Camera: Remidio Fundus on Phone; color fundus photograph; 1659 x 2212 pixels.
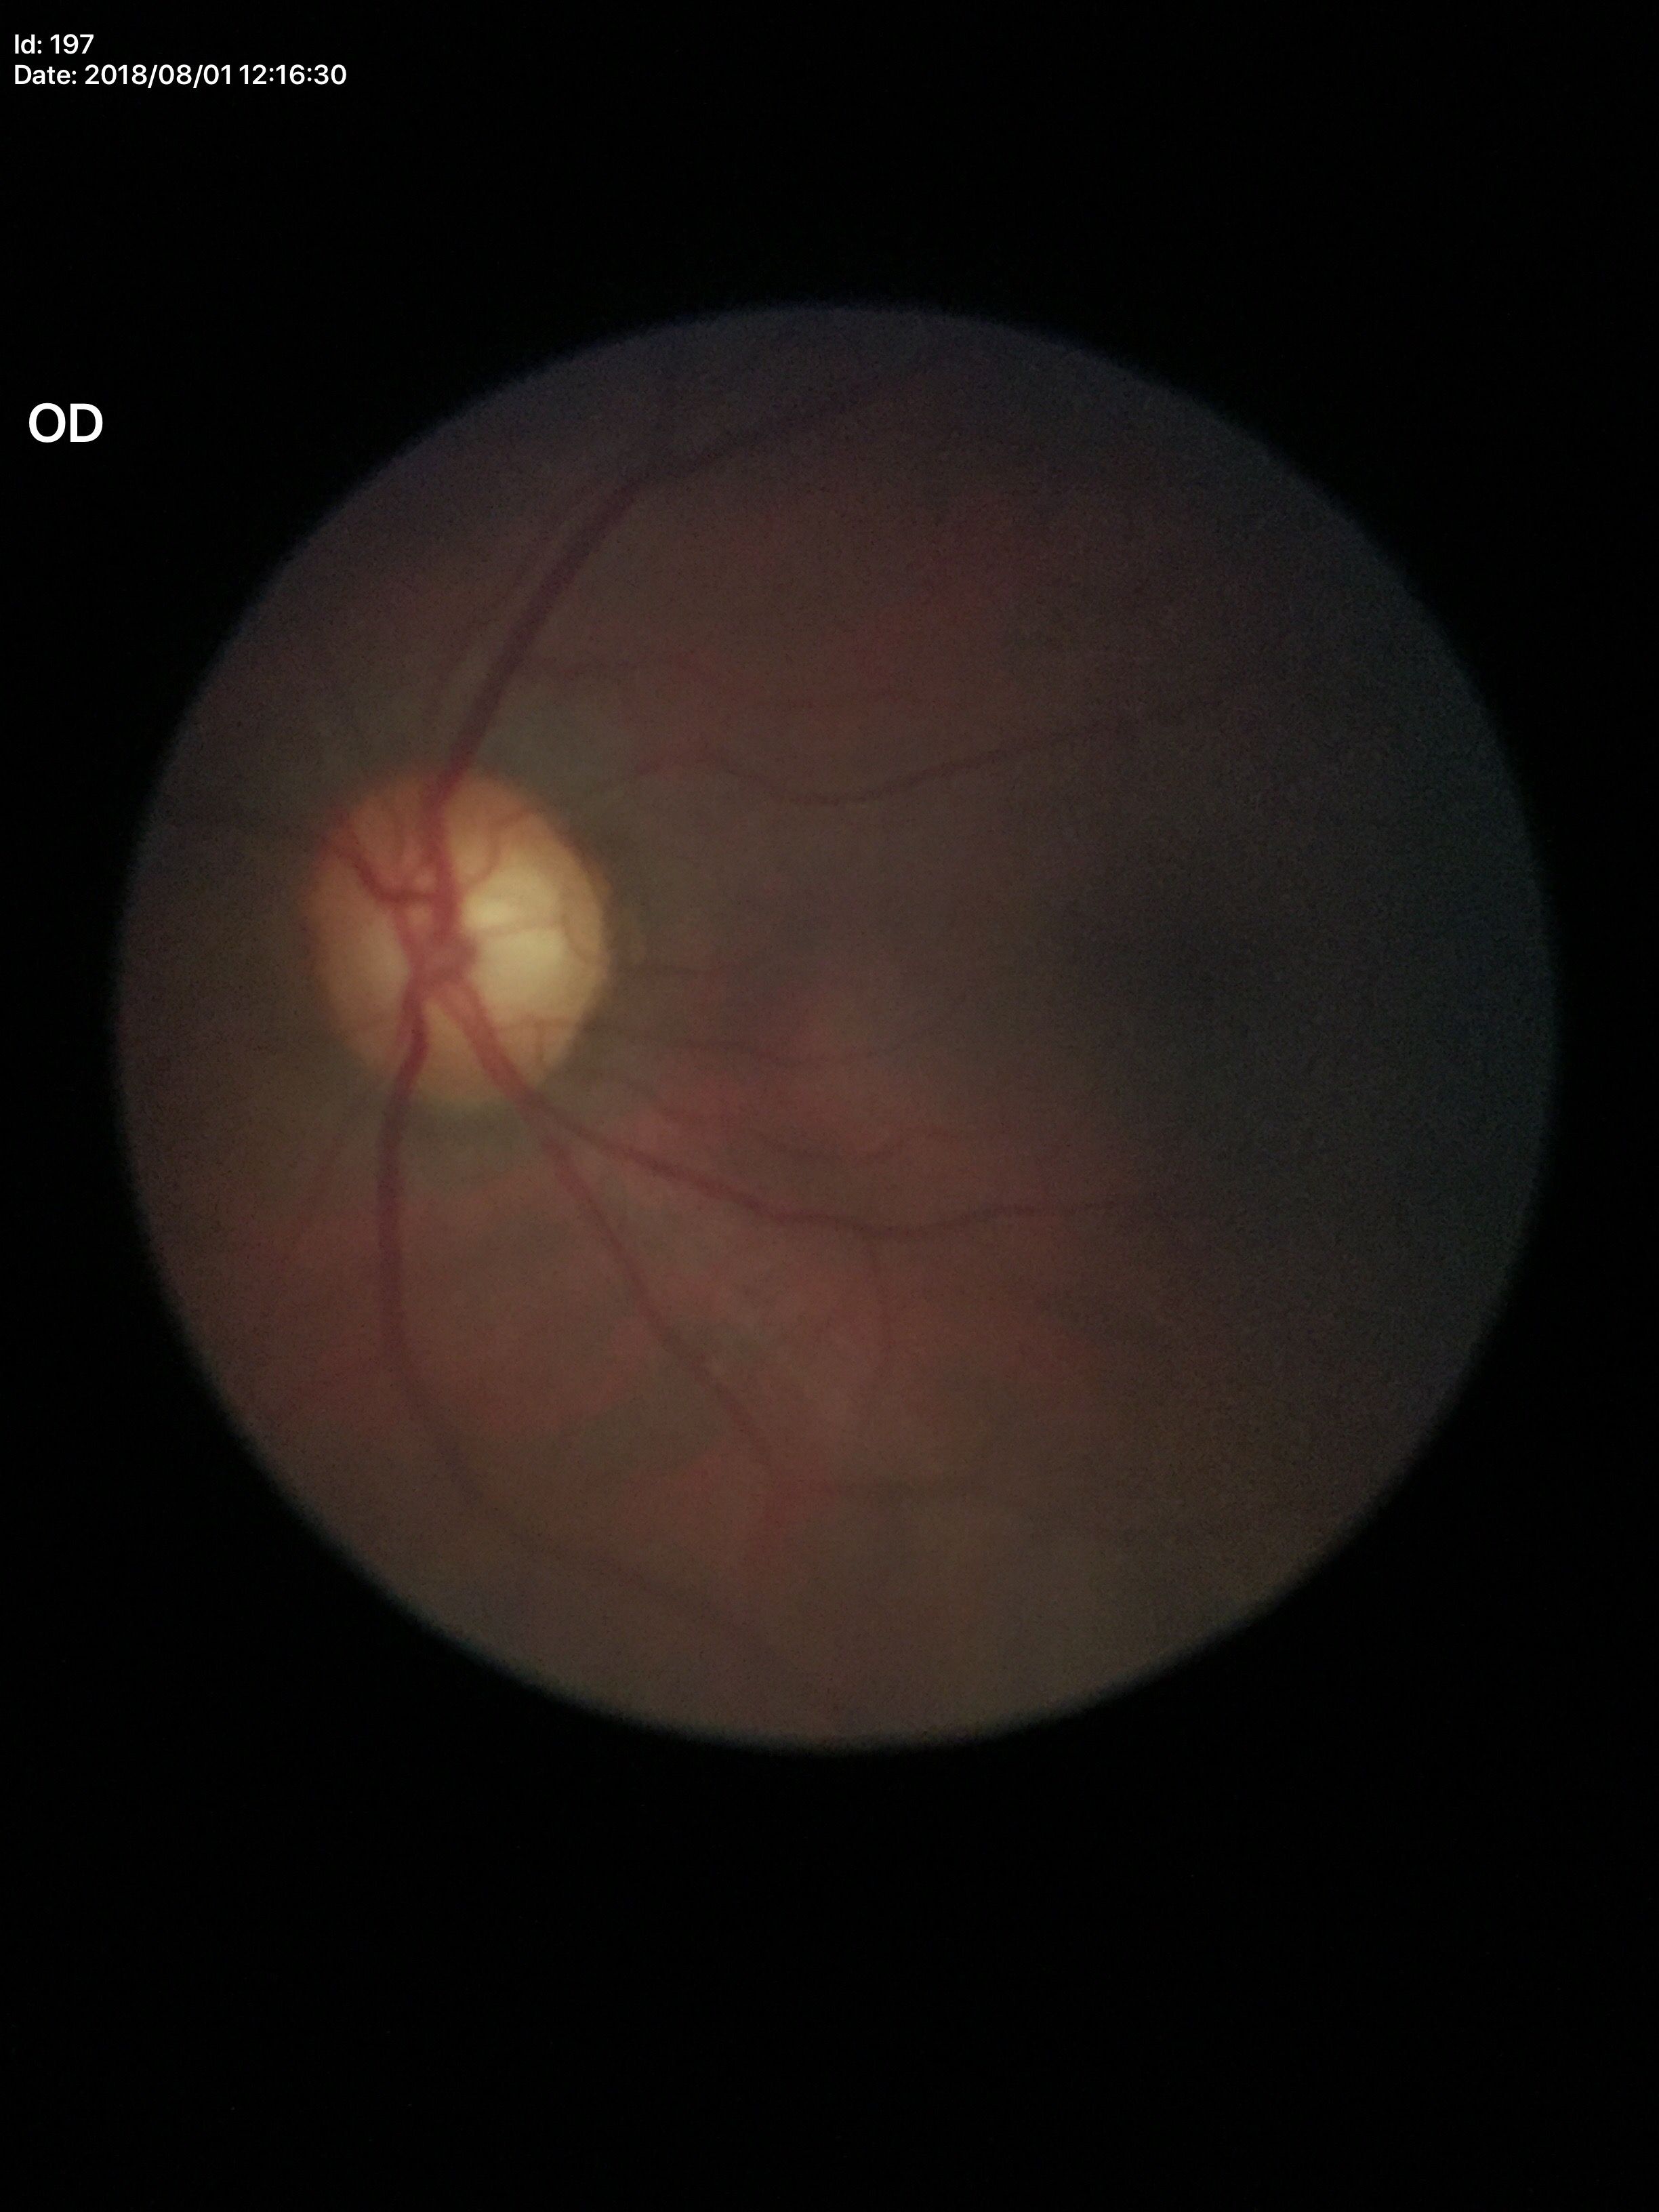 Vertical CDR (VCDR) is 0.66.
Suspicious for glaucoma.